CFP; image size 2184x1690; 45-degree field of view
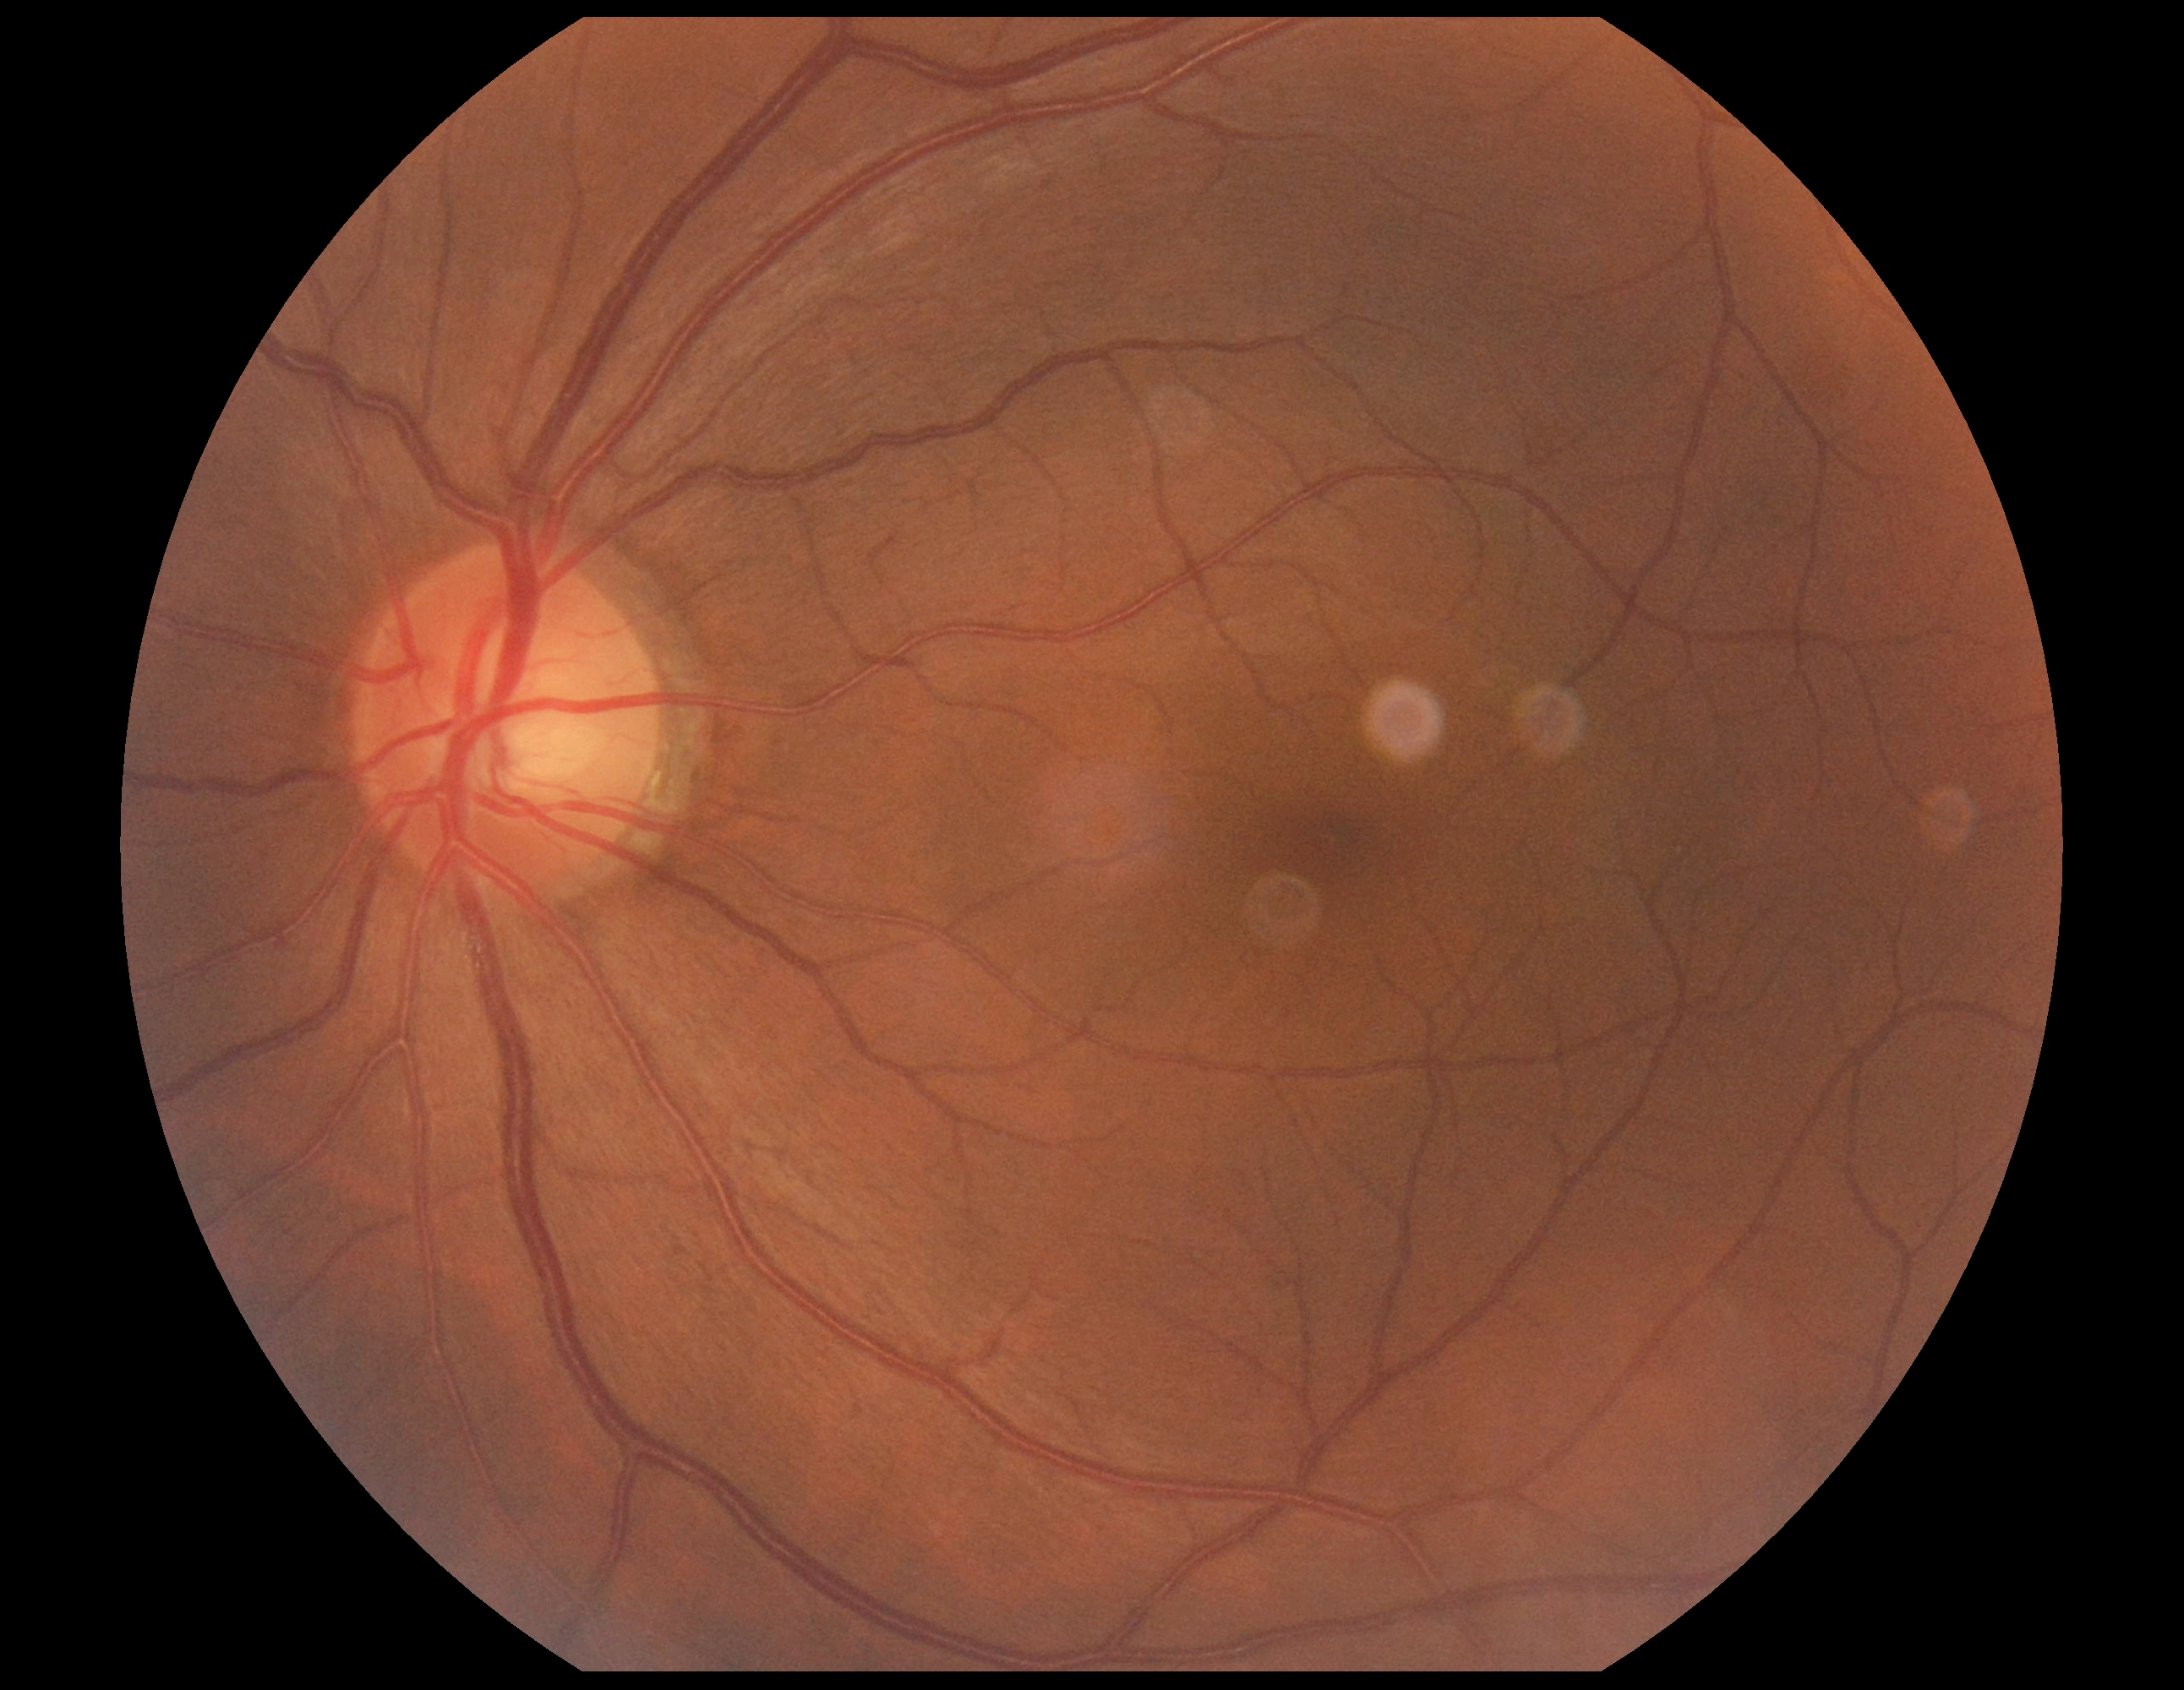
diabetic retinopathy grade = 0 (no apparent retinopathy).